Pediatric wide-field fundus photograph. Camera: Clarity RetCam 3 (130° FOV): 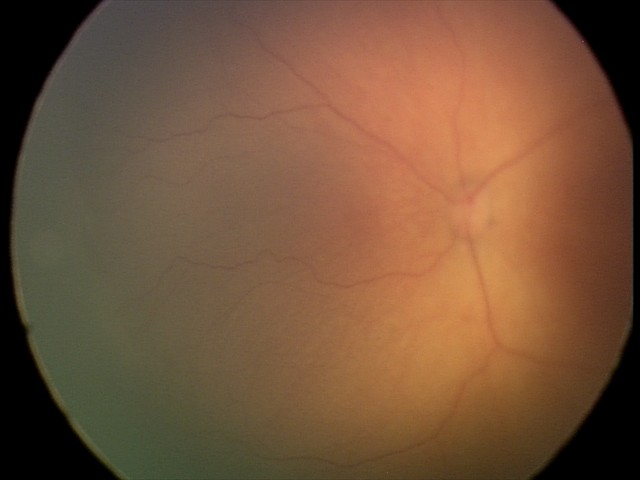 Q: What is the plus-form classification?
A: no plus disease
Q: What is the screening diagnosis?
A: retinopathy of prematurity (ROP) stage 1